Infant wide-field fundus photograph. 1440 by 1080 pixels.
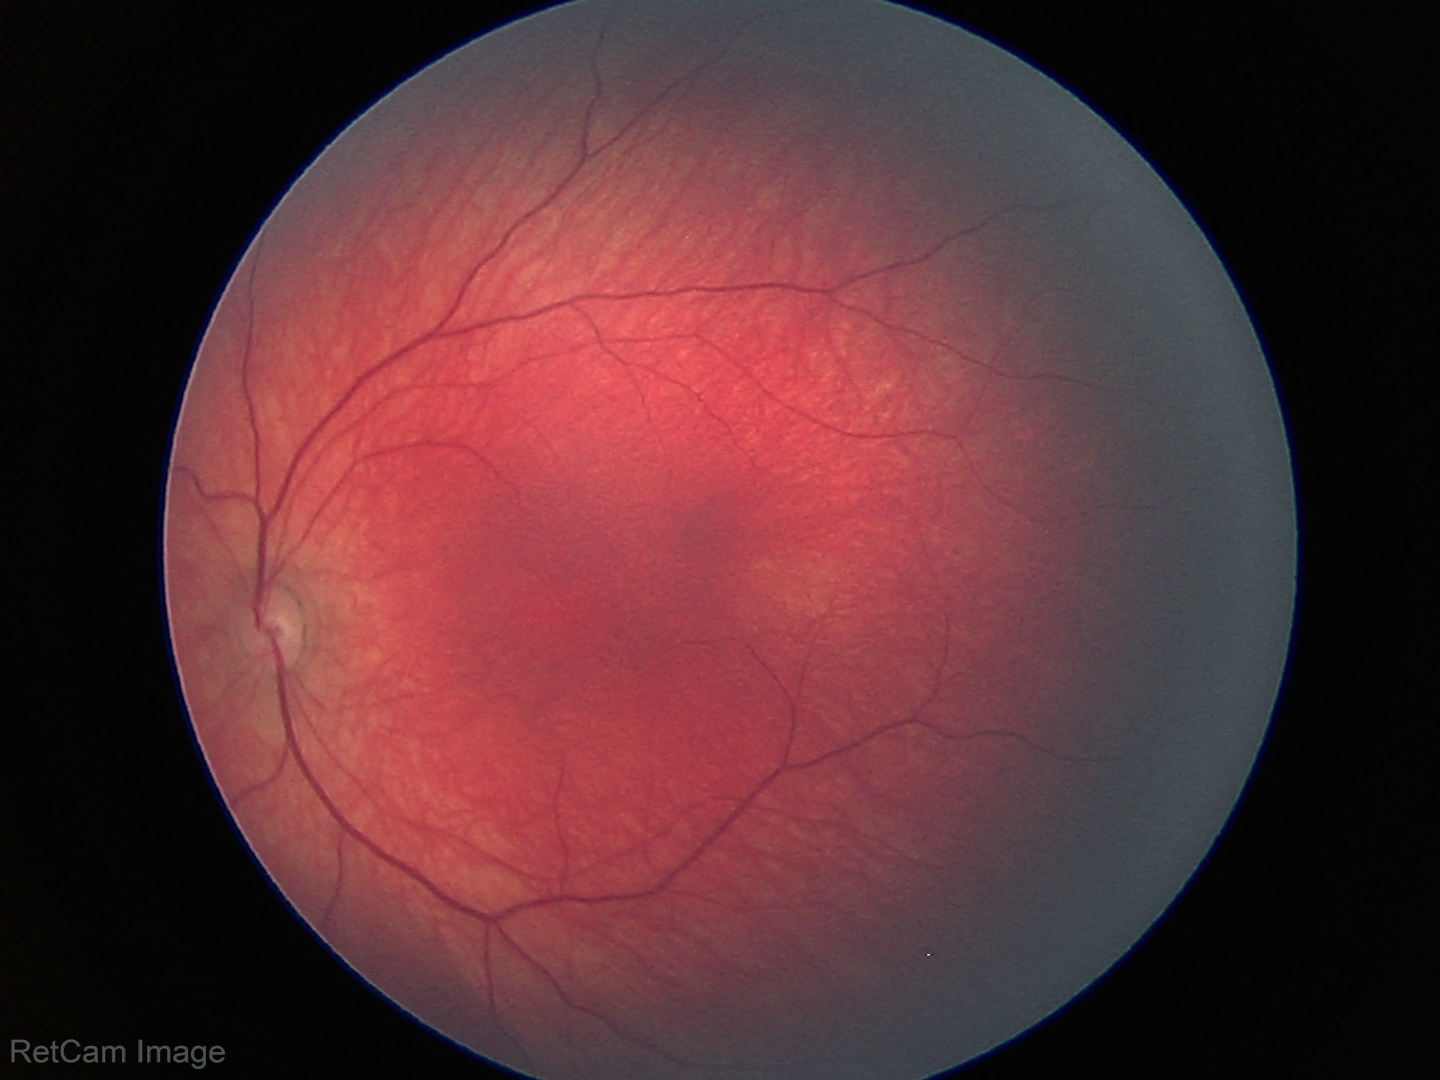 Screening examination diagnosed as physiological.